640 by 480 pixels · RetCam wide-field infant fundus image · 130° field of view (Clarity RetCam 3) — 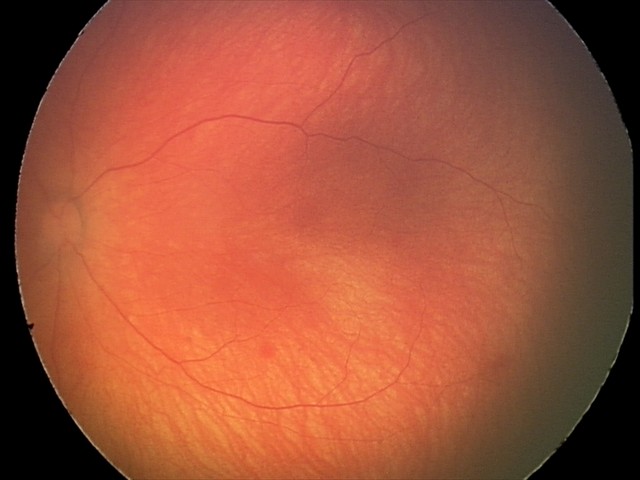 Examination diagnosed as retinal hemorrhages.